45-degree field of view:
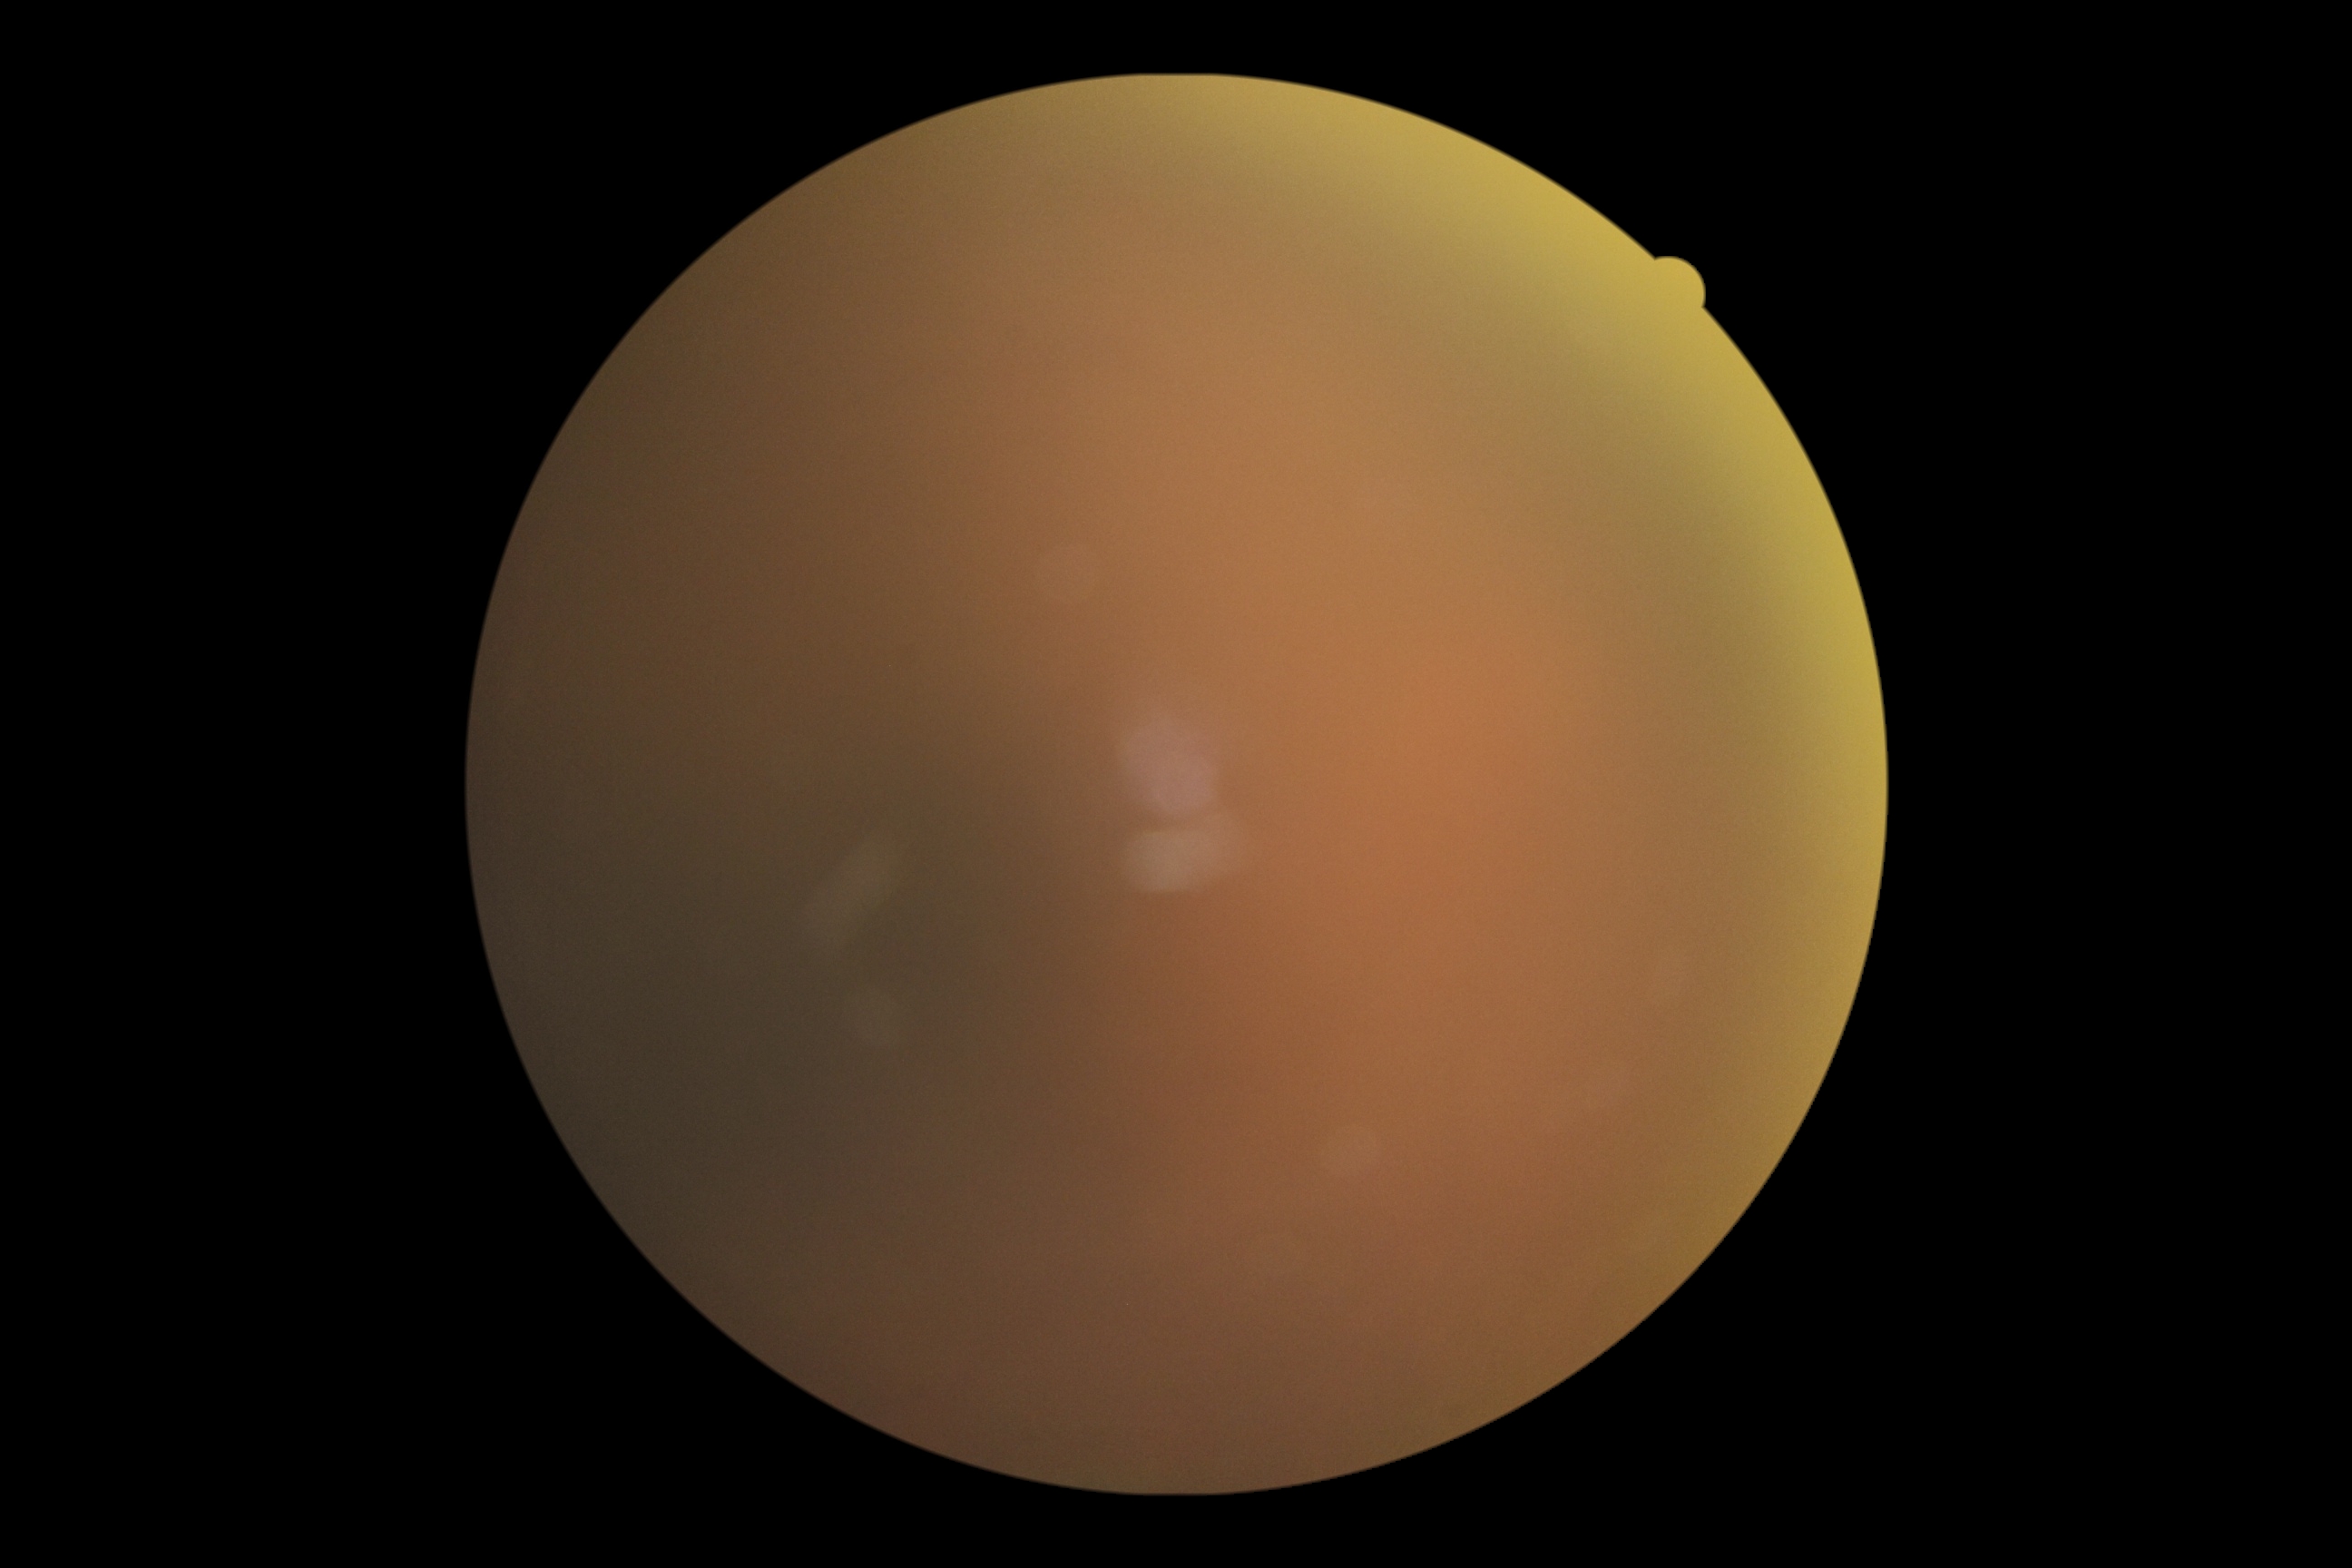 Ungradable image — DR severity cannot be determined. Retinopathy is ungradable due to poor image quality.